Davis DR grading, 45 degree fundus photograph:
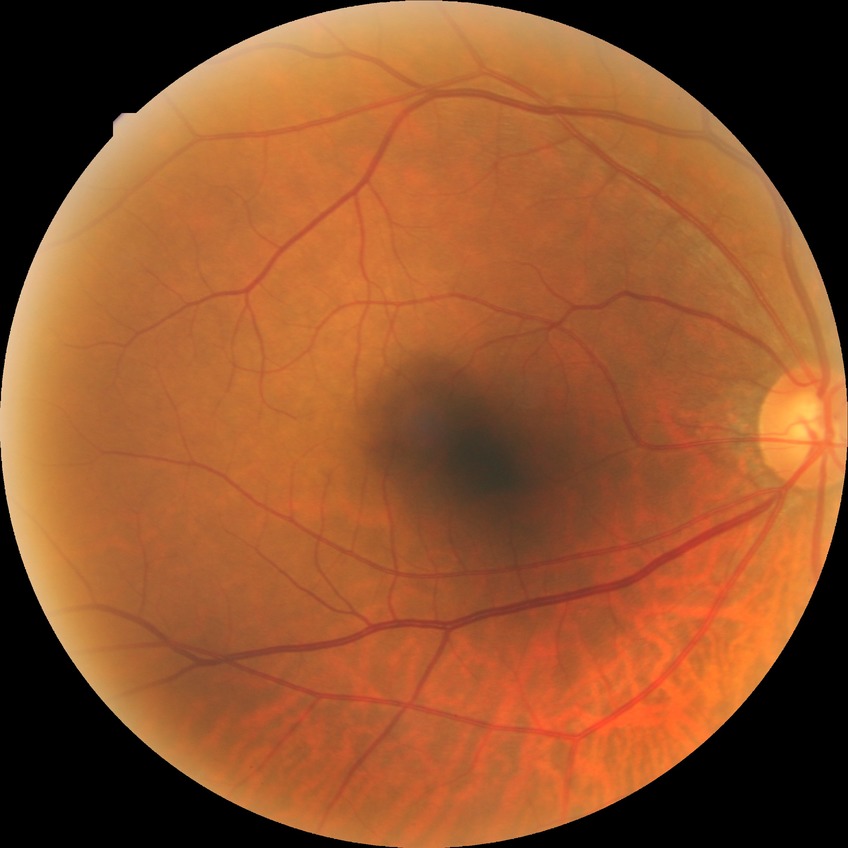 Diabetic retinopathy grade is no diabetic retinopathy.